Retinal fundus photograph, 2352x1568px.
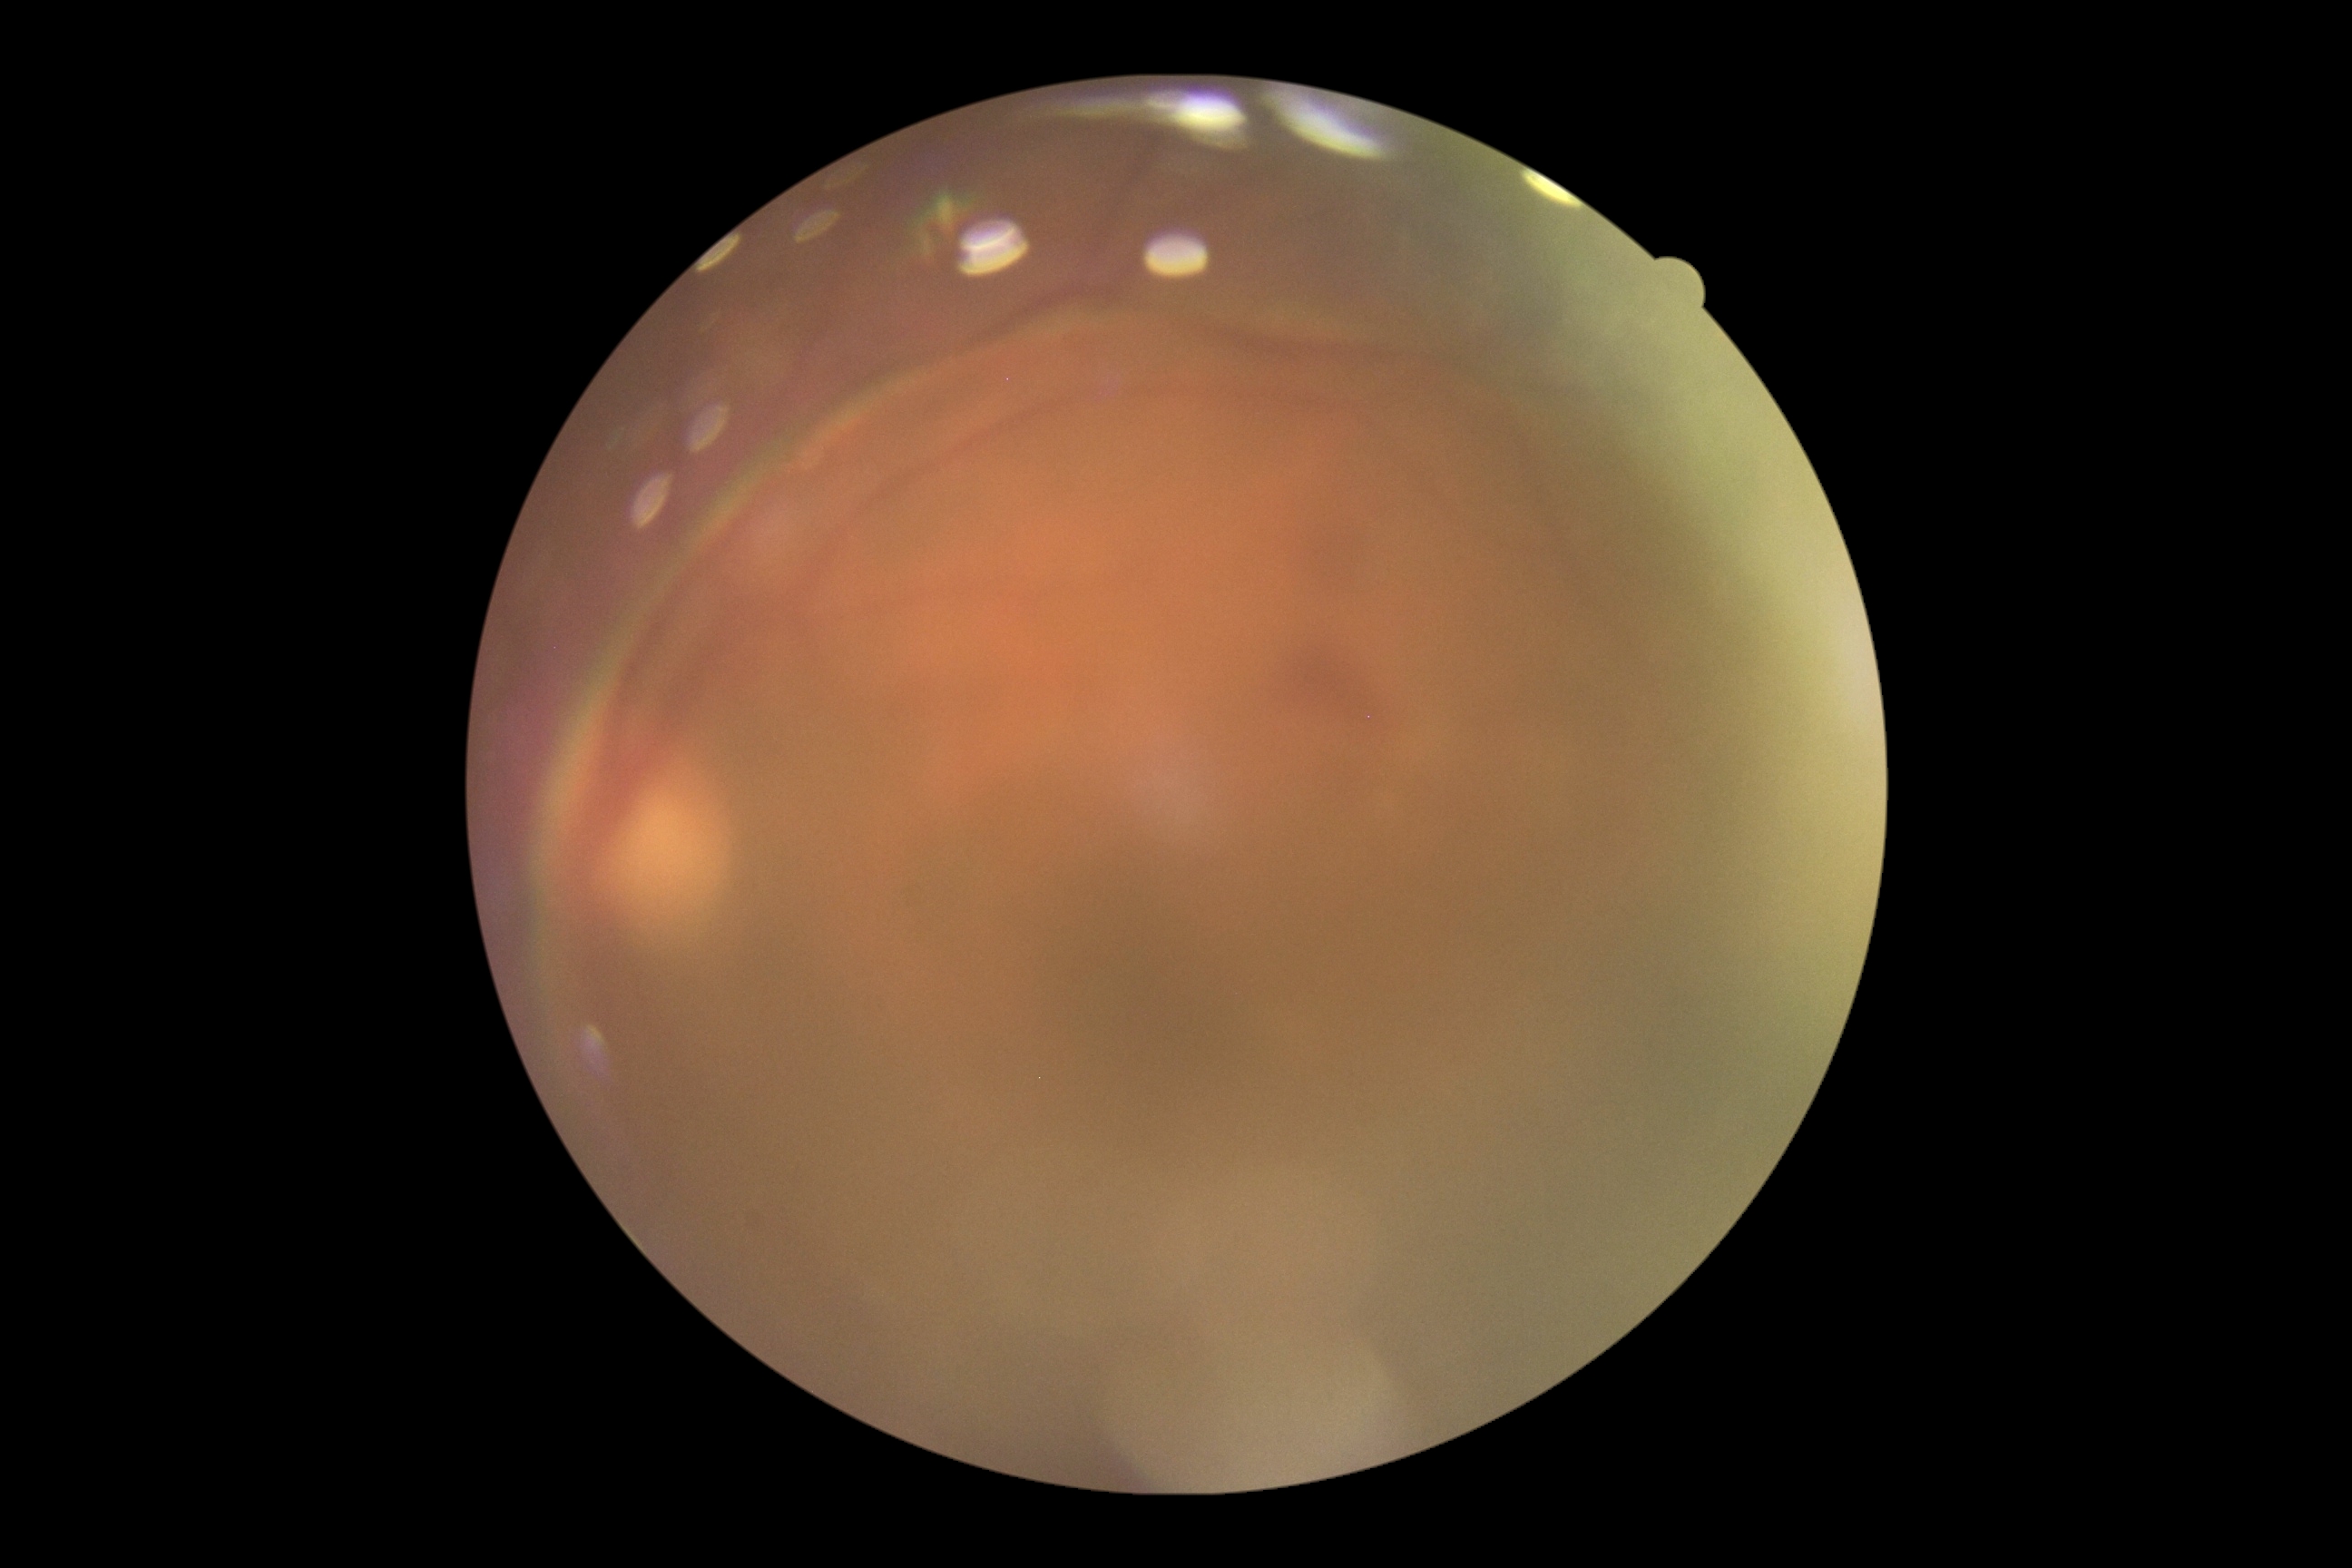

DR severity: grade 2 (moderate NPDR).